No pharmacologic dilation; modified Davis grading
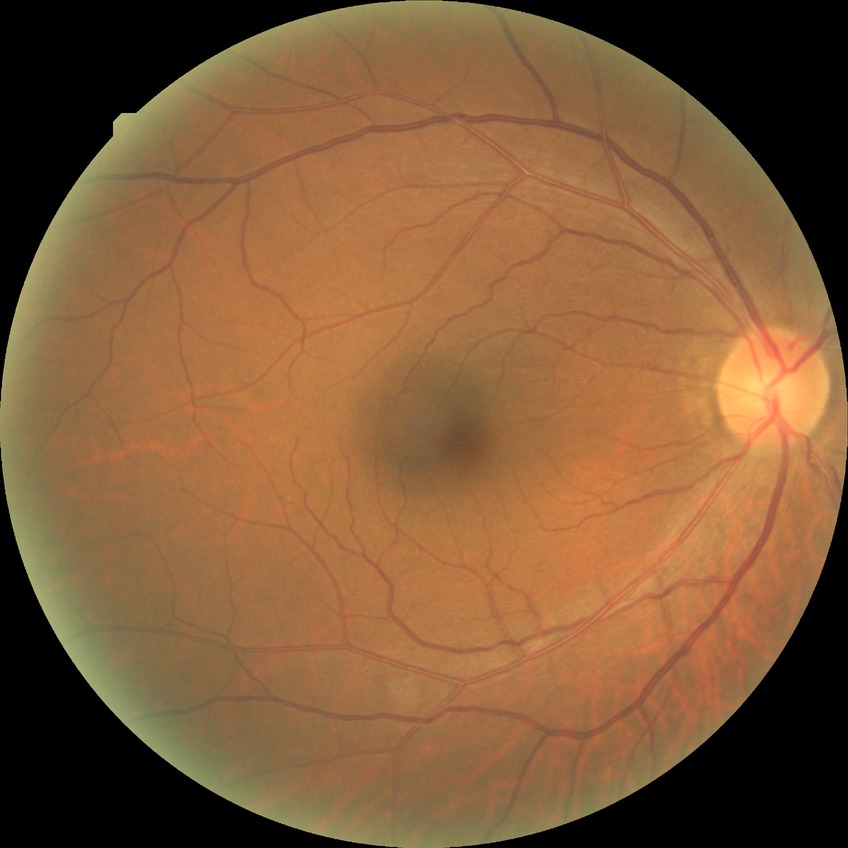
DR impression=no apparent DR, modified Davis grade=NDR.